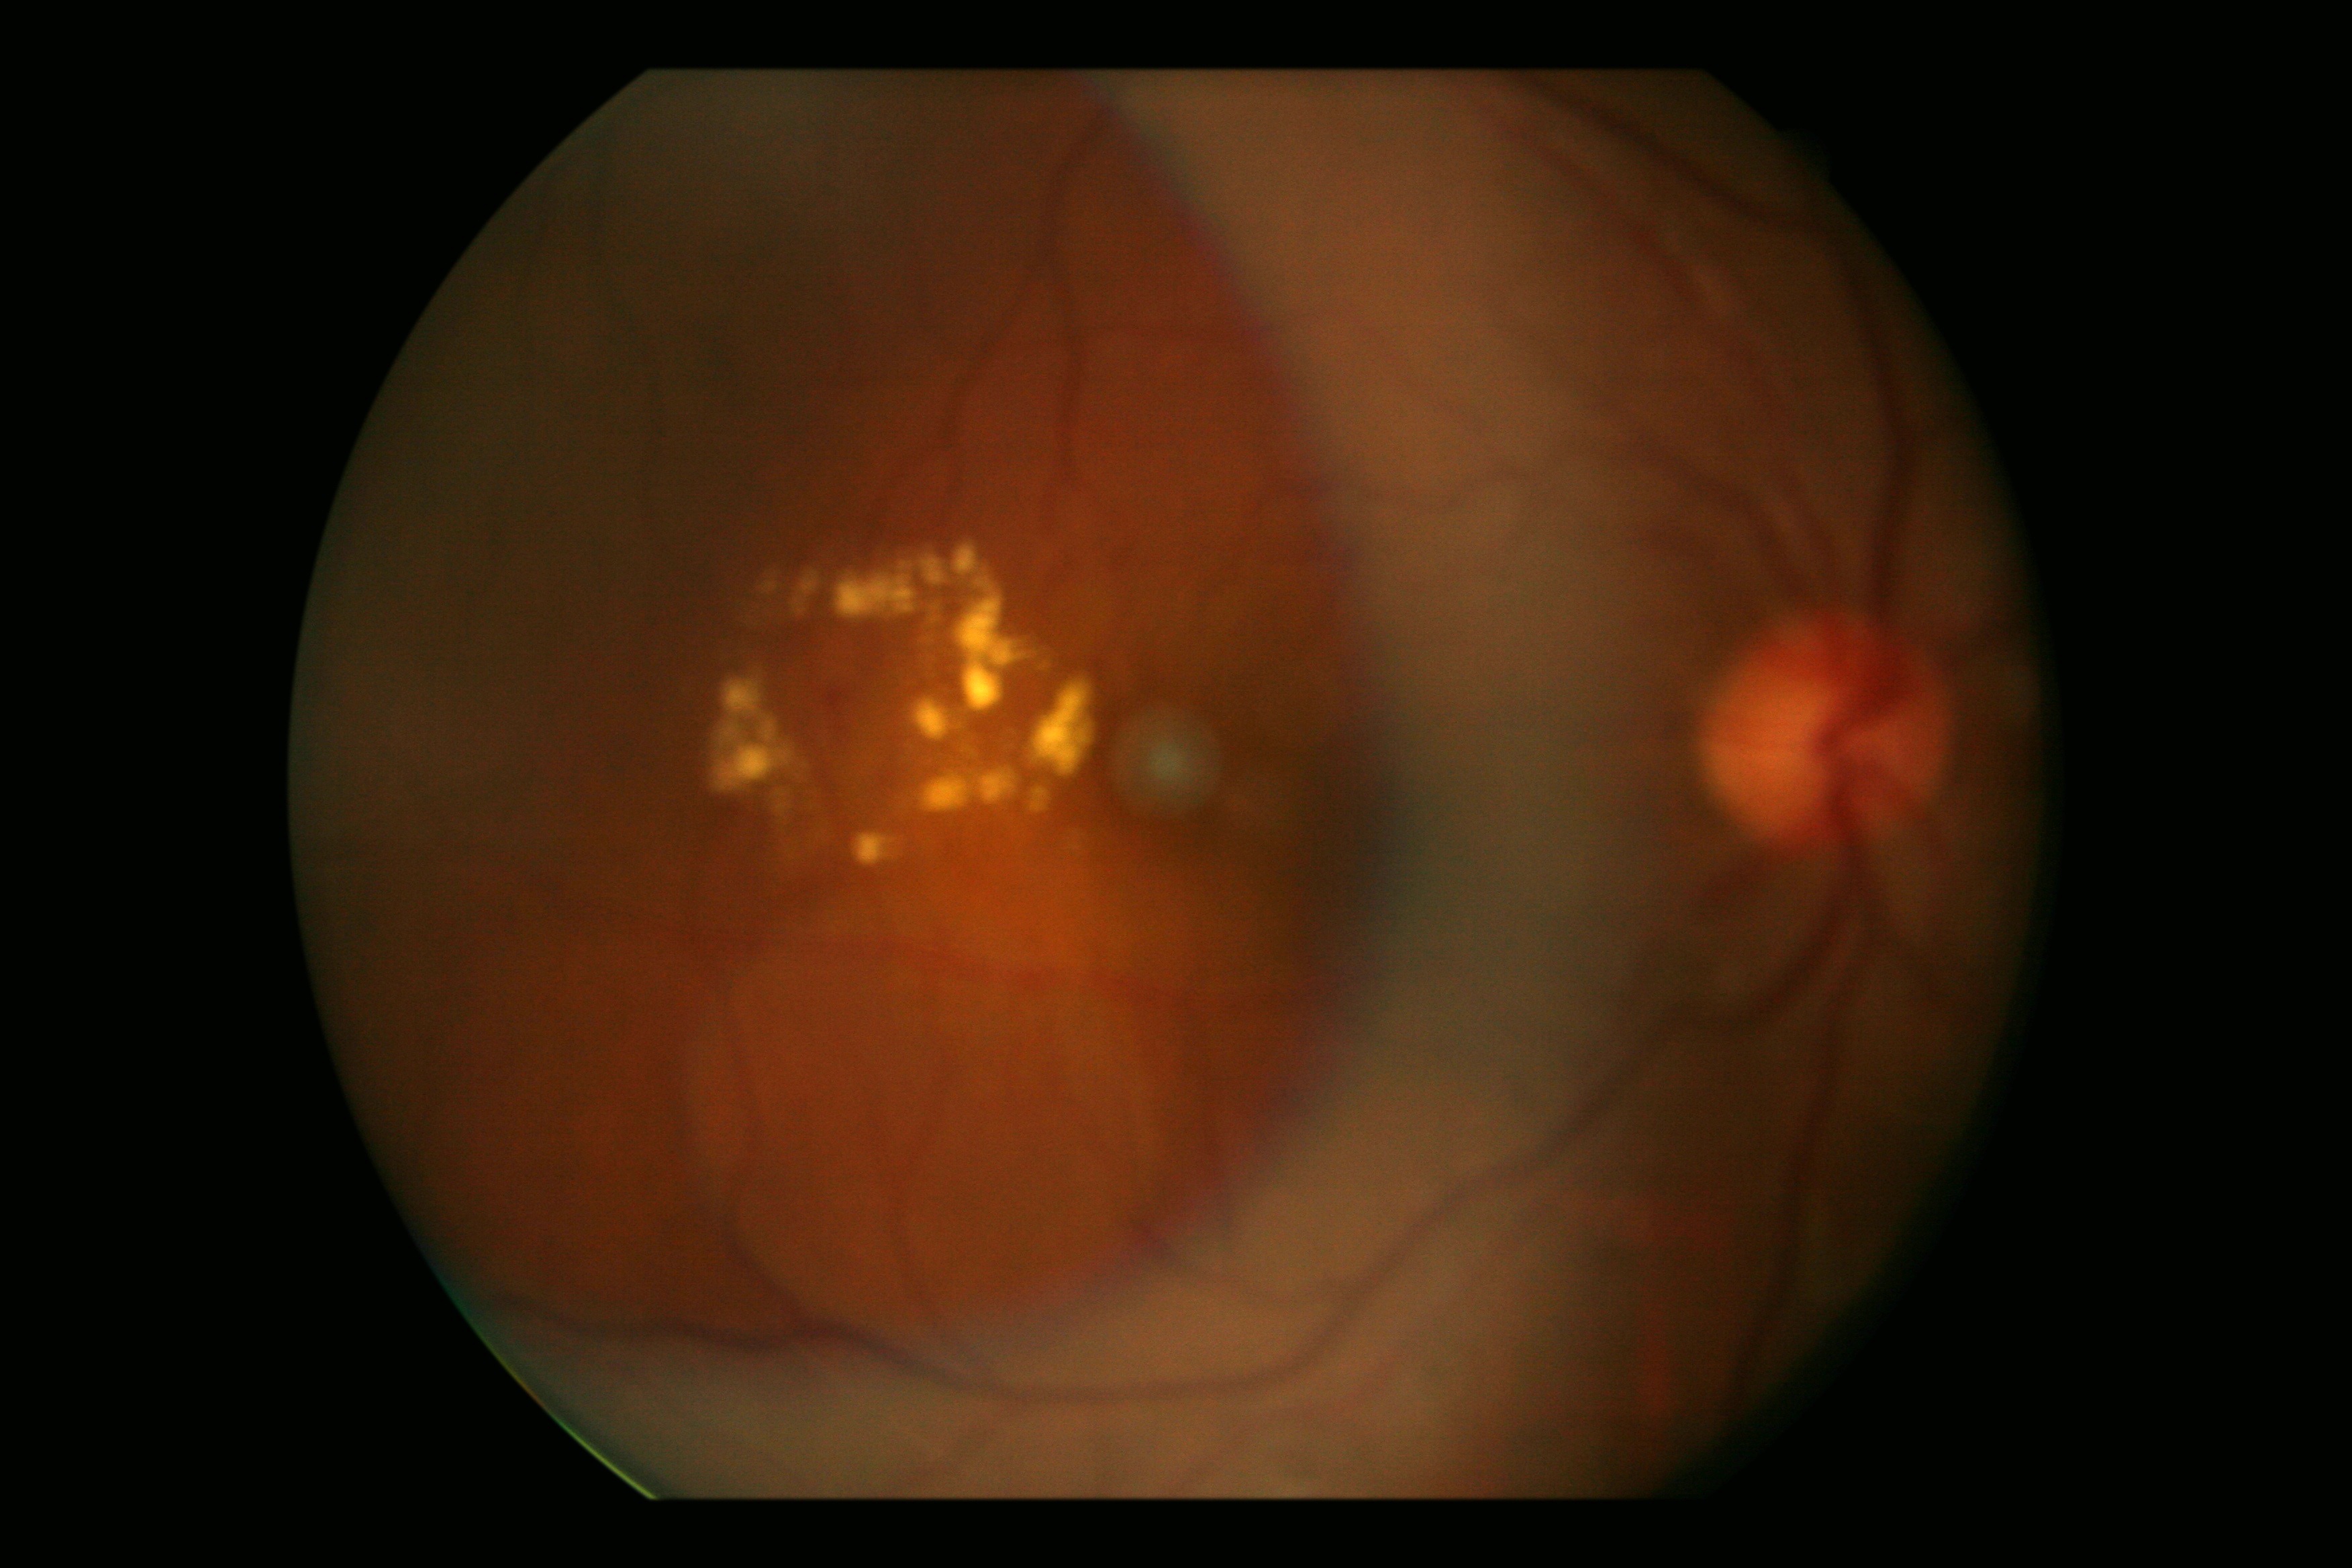
diabetic retinopathy=grade 2 (moderate NPDR).